Fundus photo: 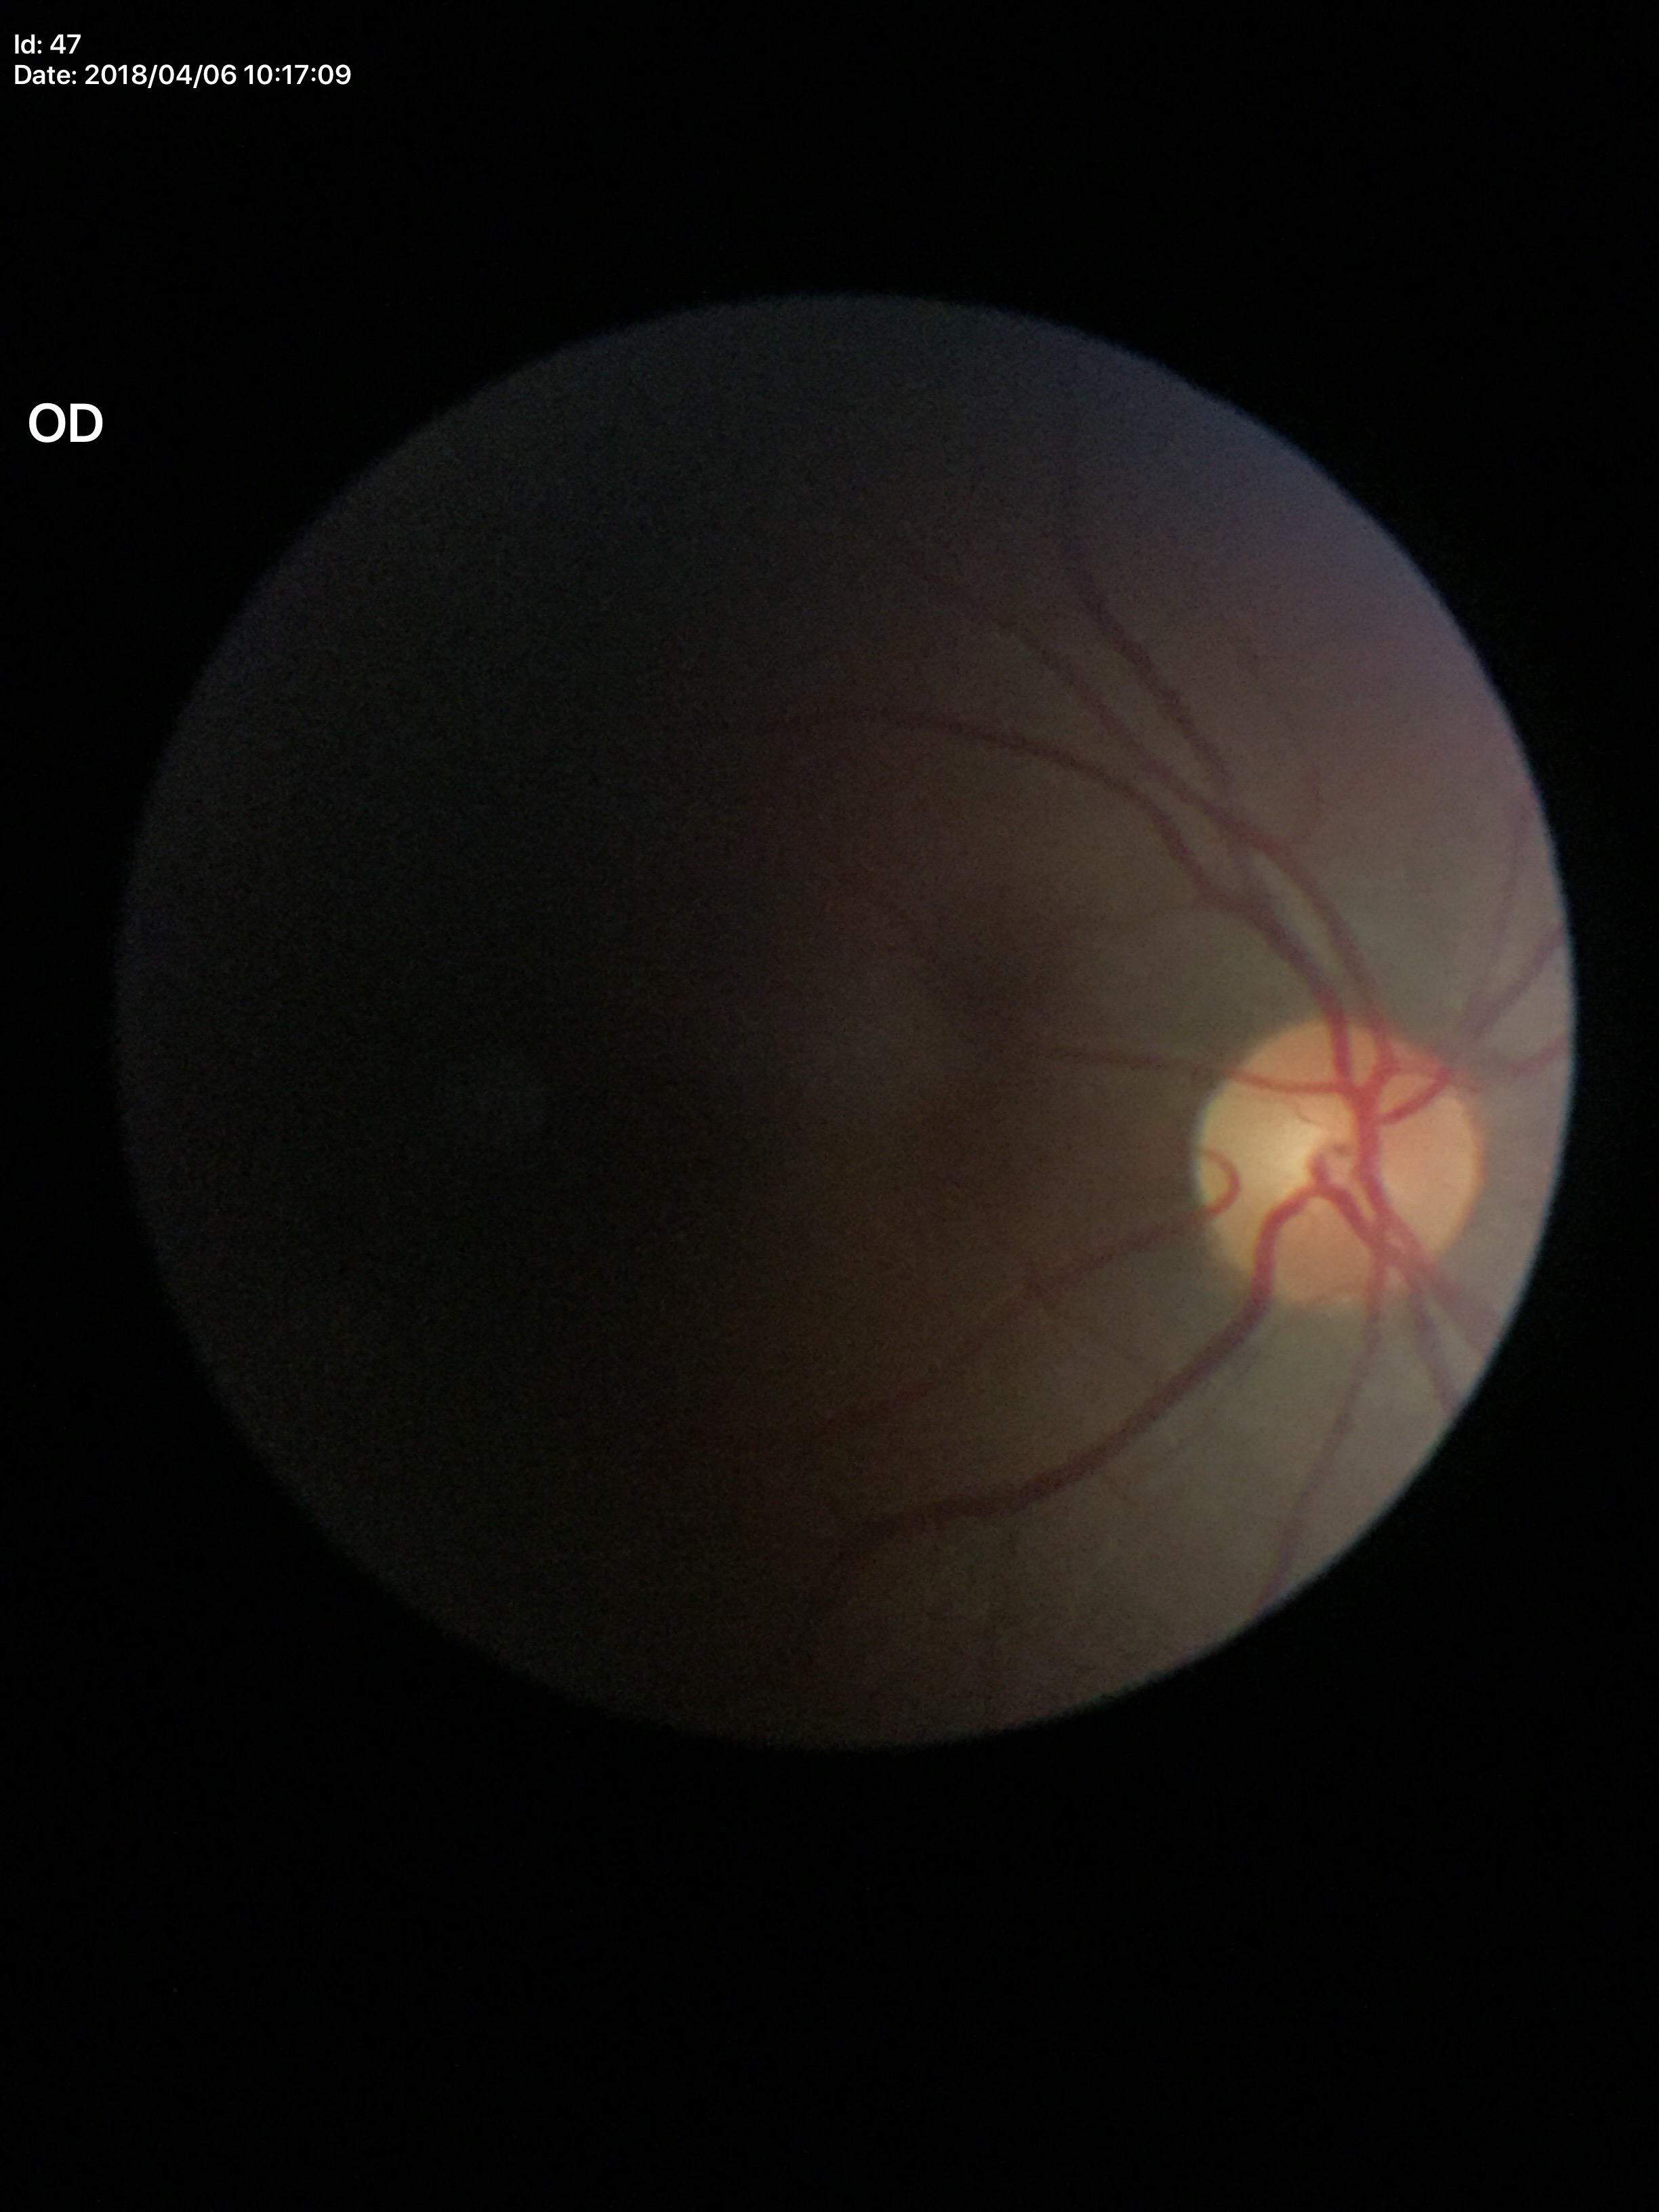

Glaucoma impression: negative. VCDR: 0.51. HCDR: 0.45.